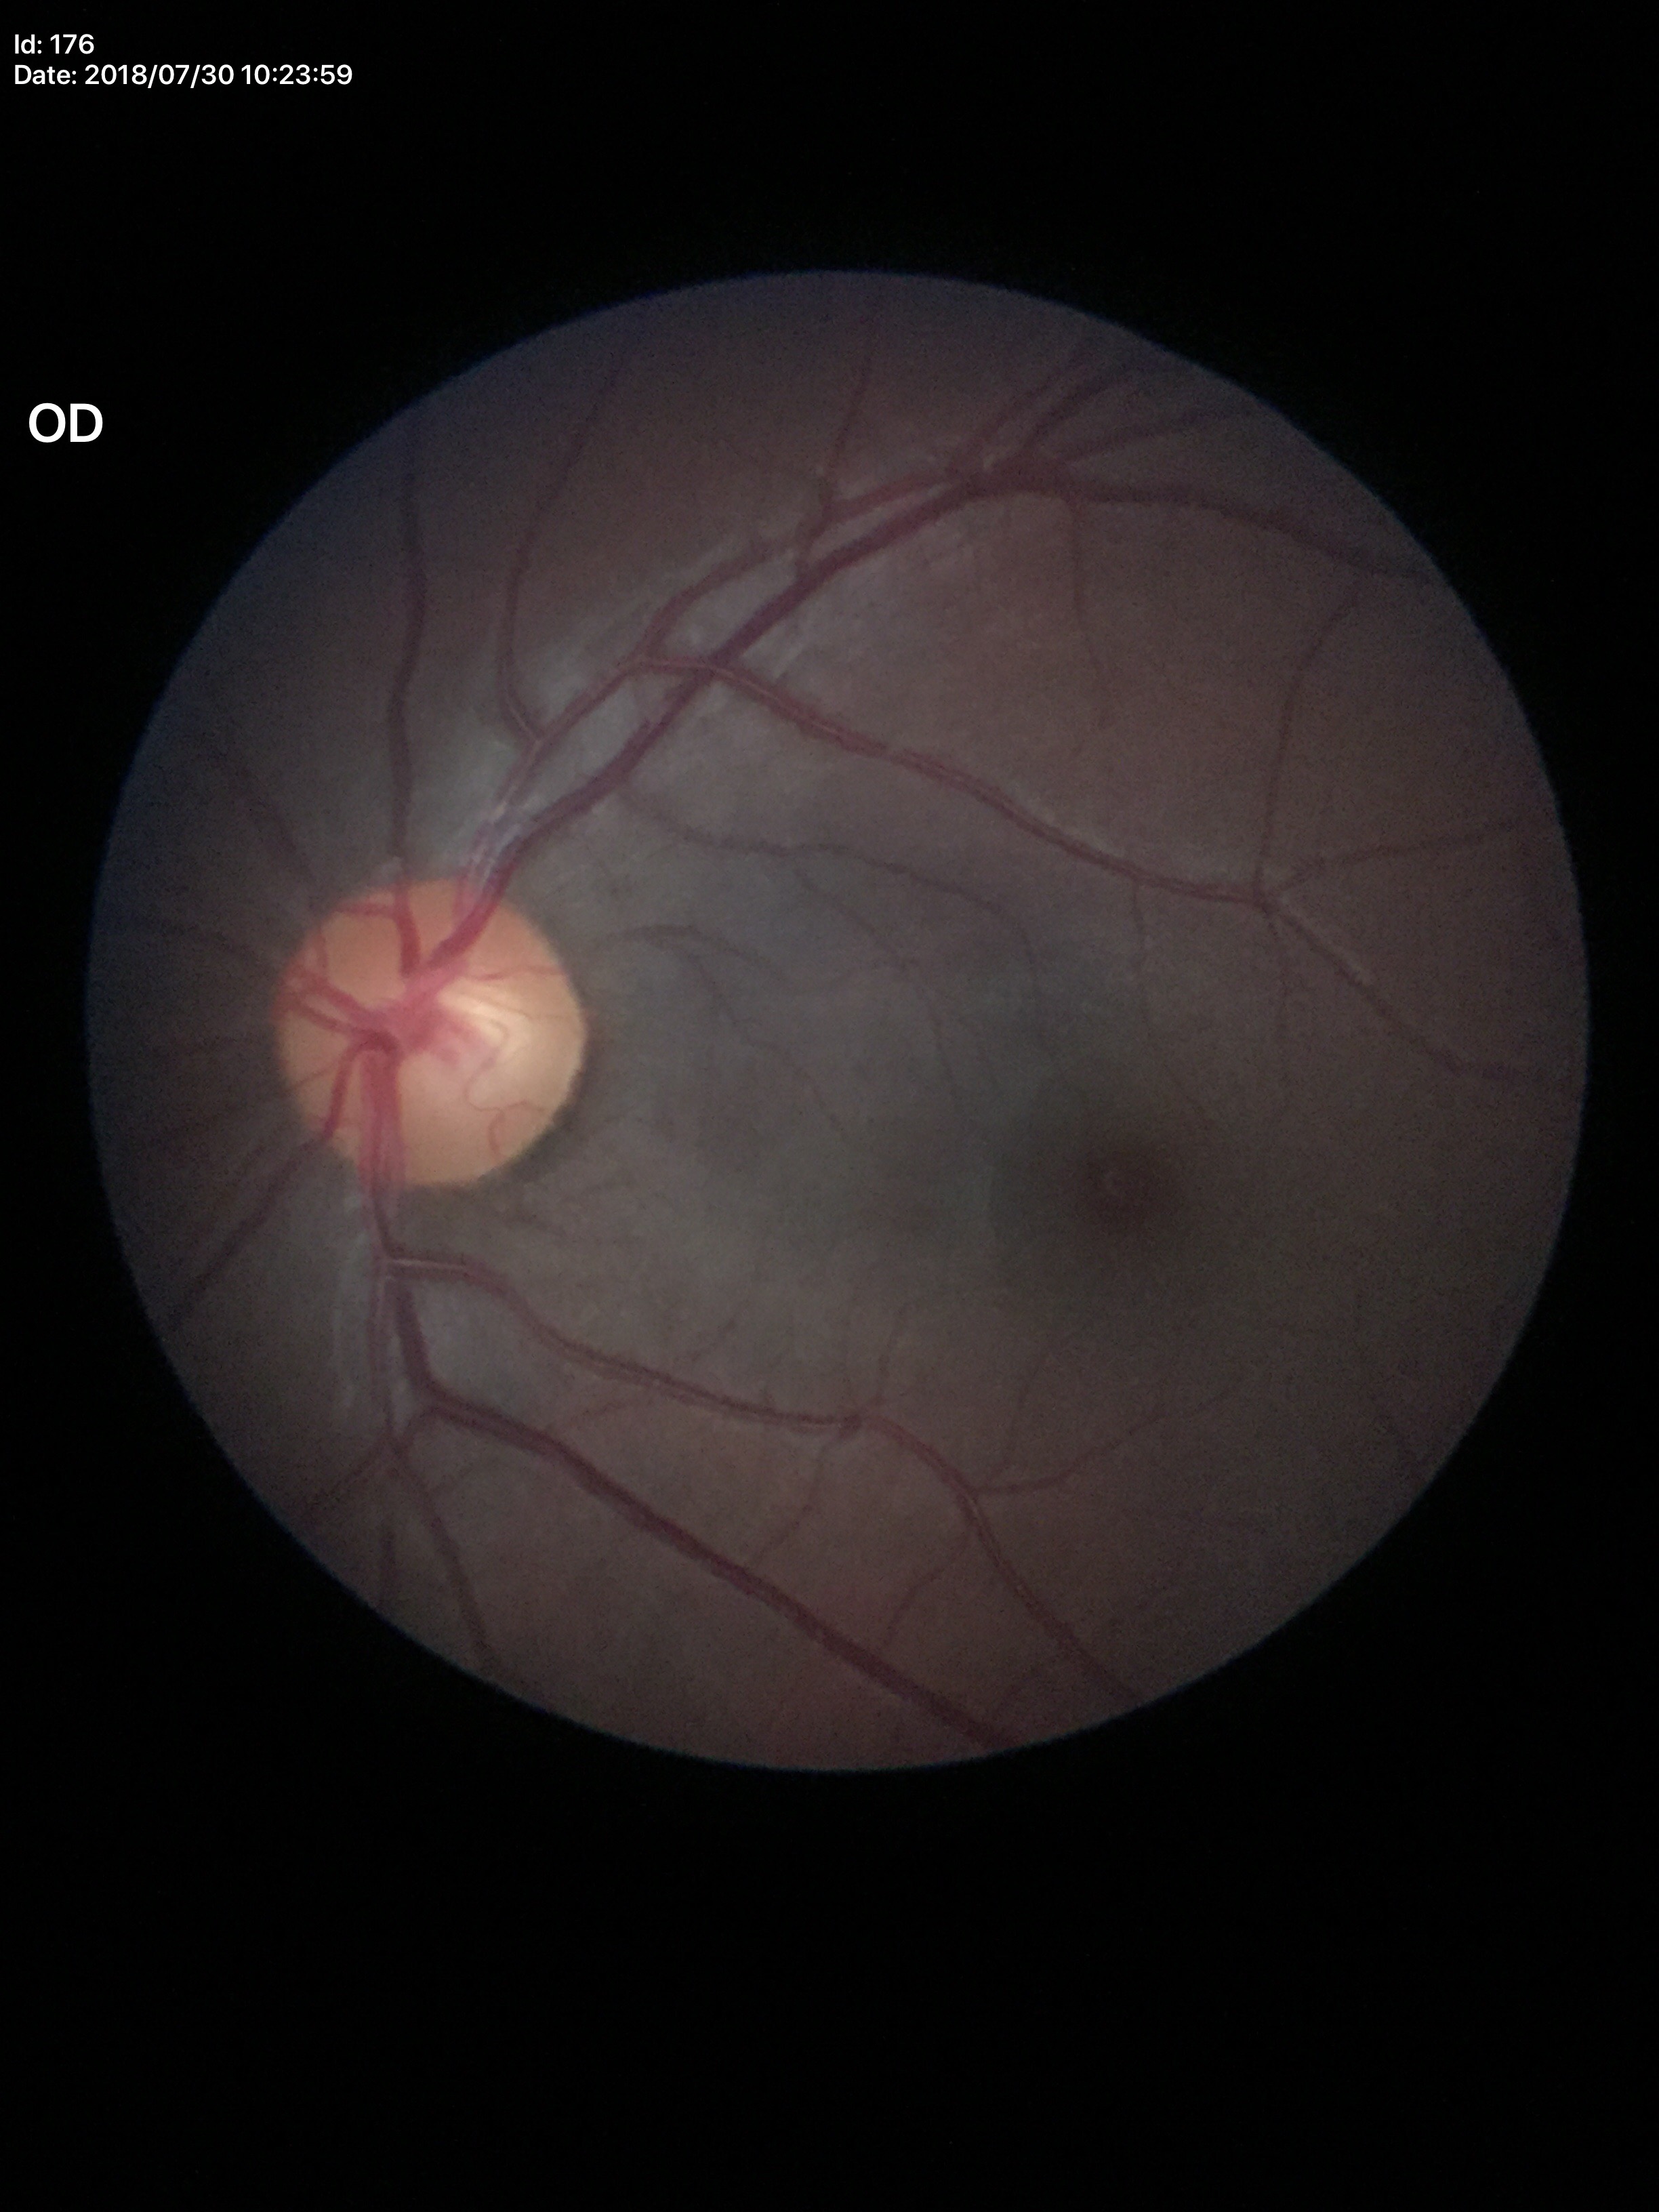
Vertical C/D ratio: 0.49.
Glaucoma assessment: negative (1 of 5 graders flagged glaucoma suspect).